1659x2212; CFP
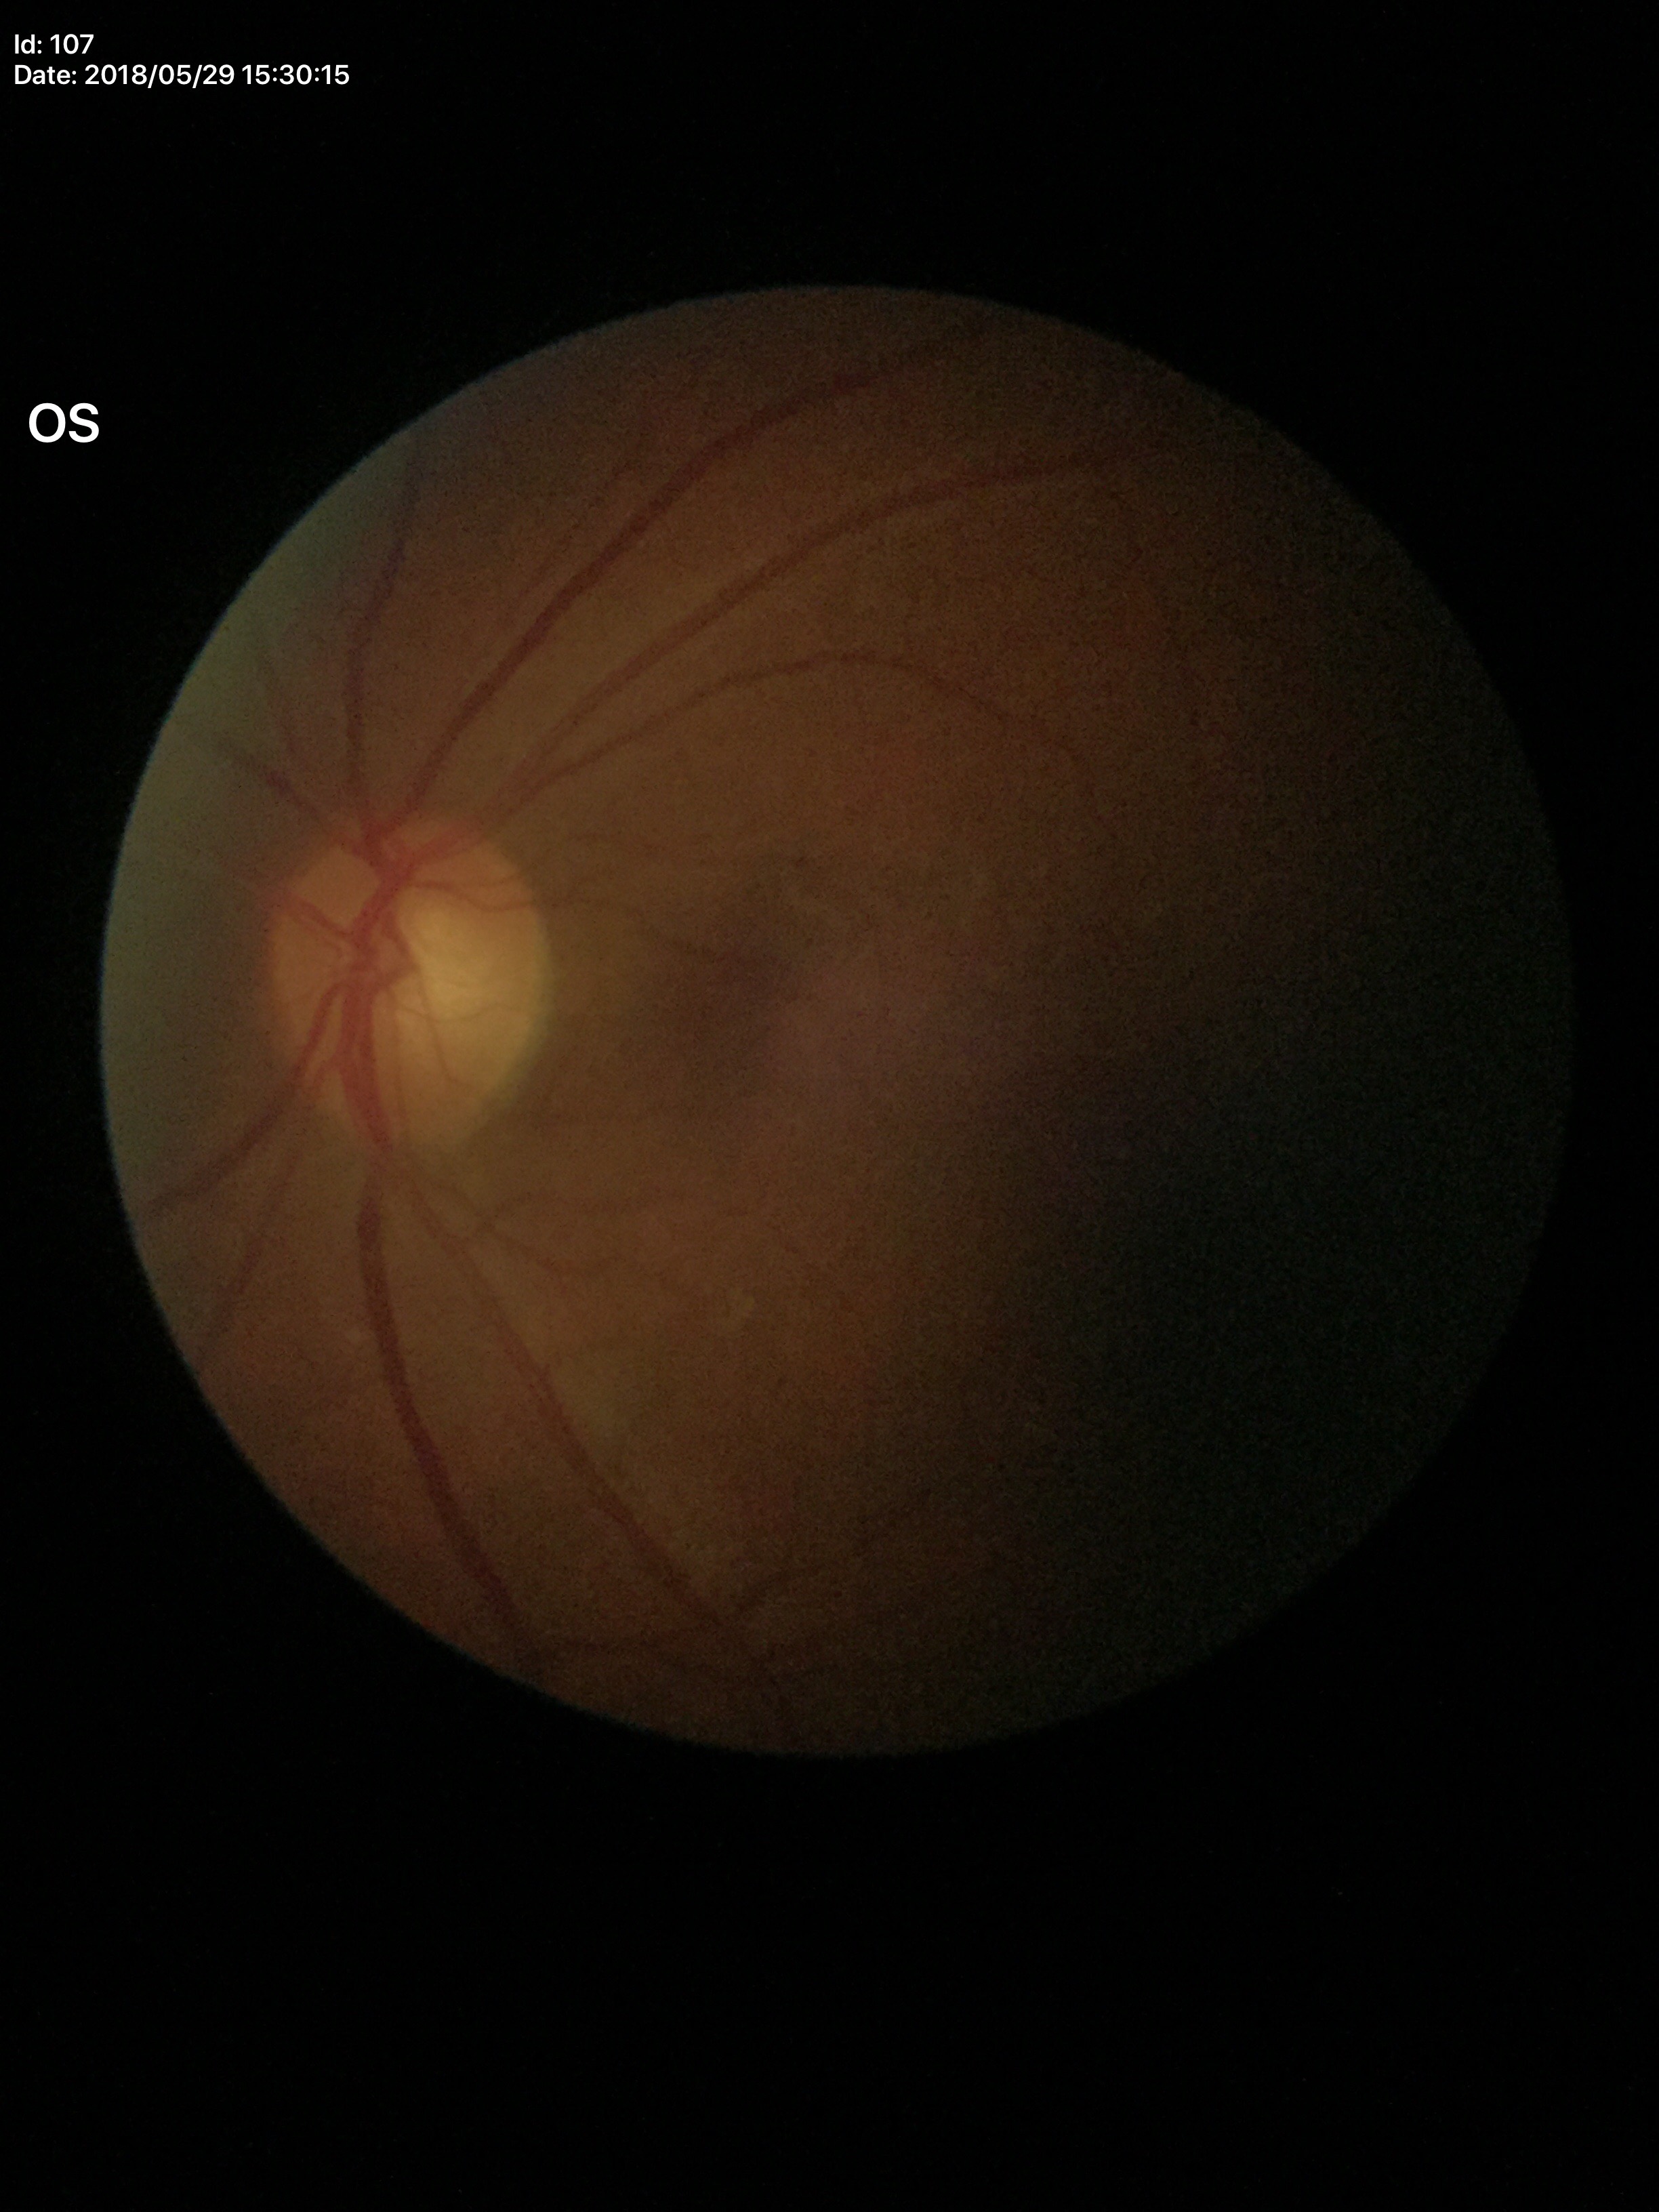
Q: What is the VCDR?
A: 0.58
Q: Is there glaucoma suspicion?
A: not suspect